Acquired with a NIDEK AFC-230. Modified Davis classification:
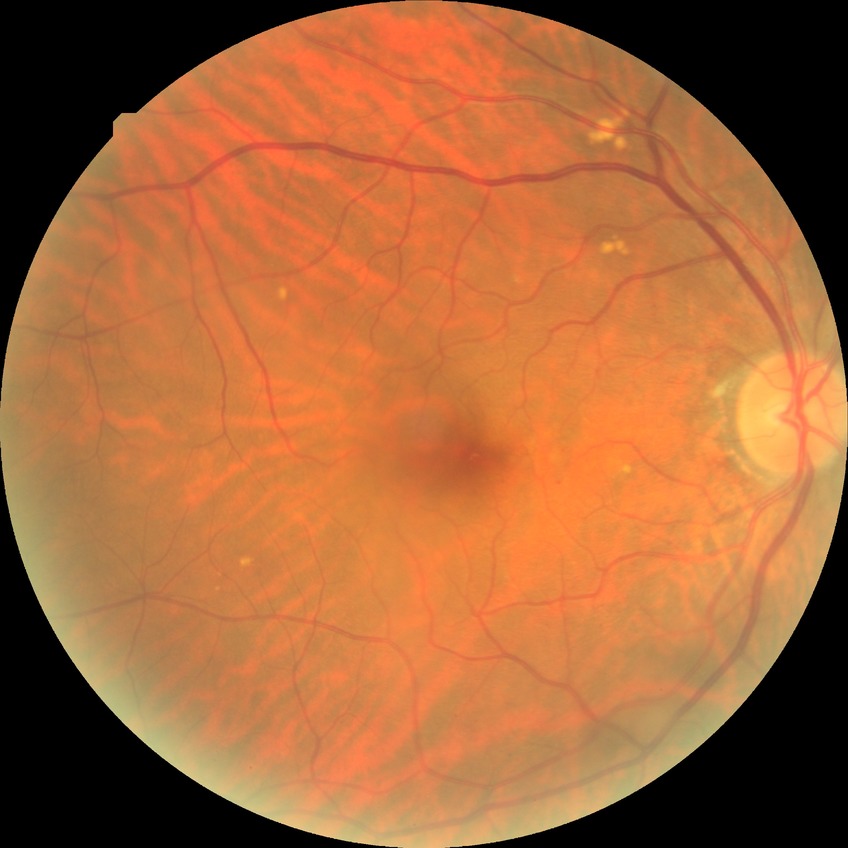
Diabetic retinopathy (DR) is no diabetic retinopathy (NDR).